1536 by 1152 pixels. Fundus photo. FOV: 45 degrees:
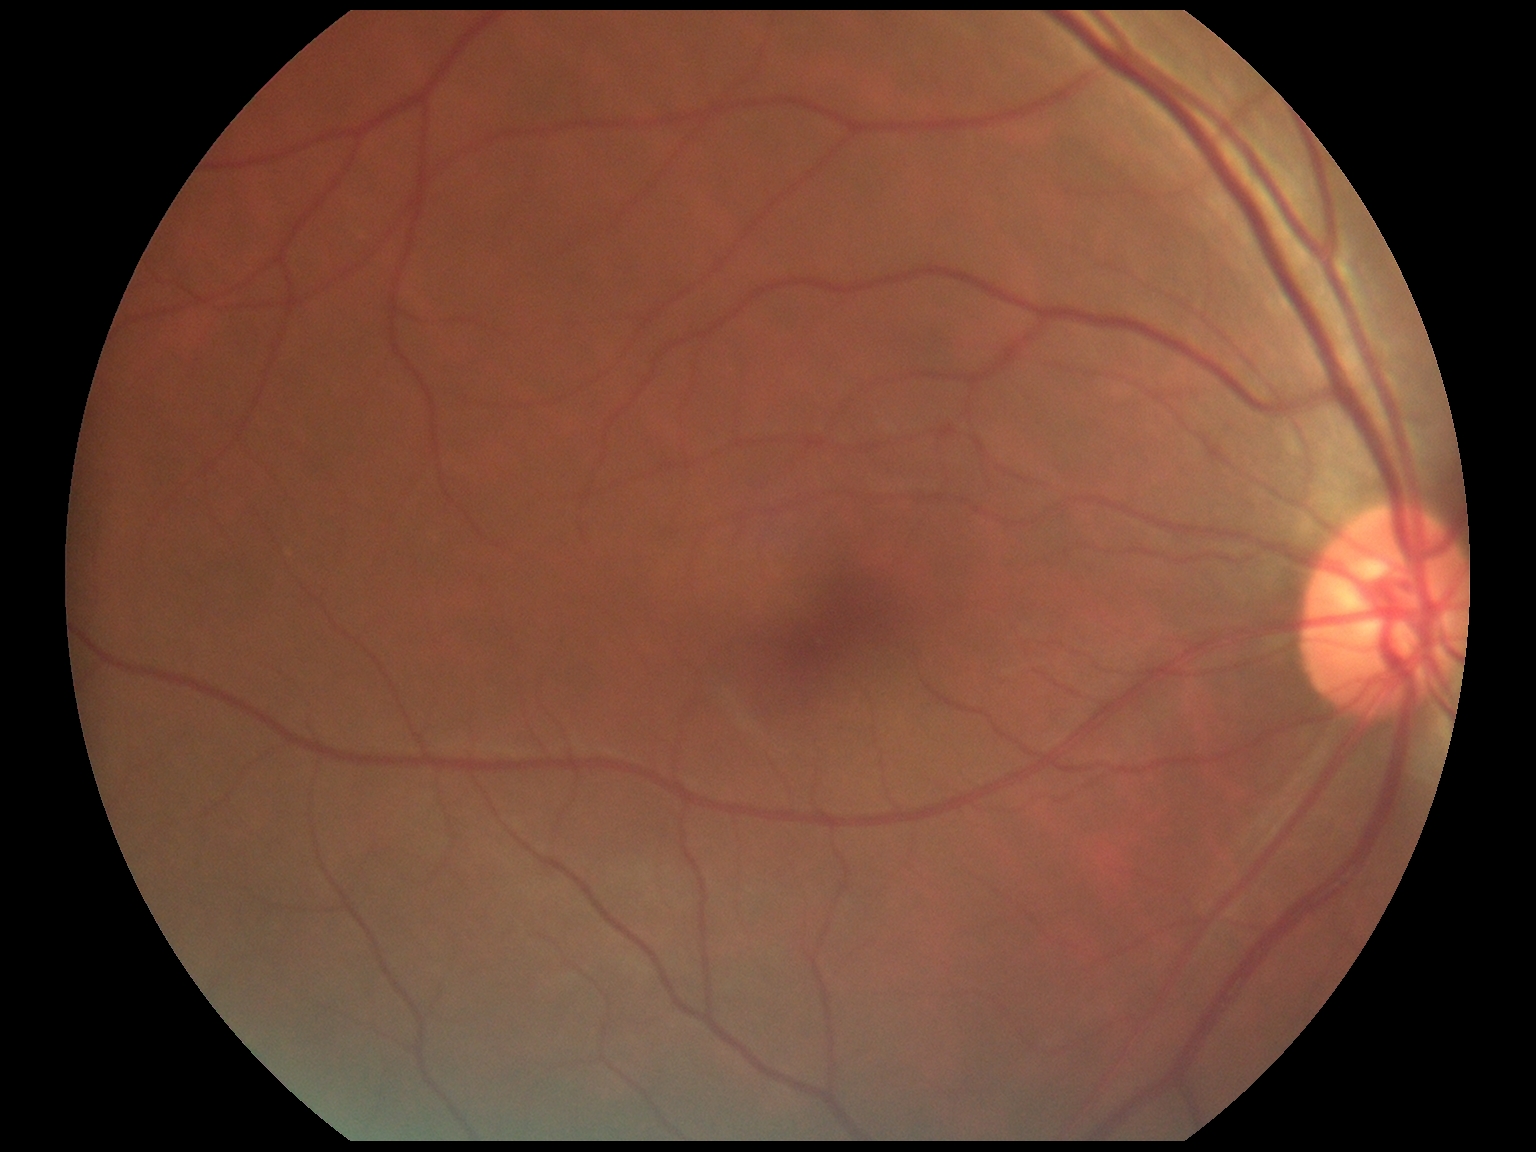 {"dr_grade": "no apparent diabetic retinopathy (0)"}